2048 by 1536 pixels:
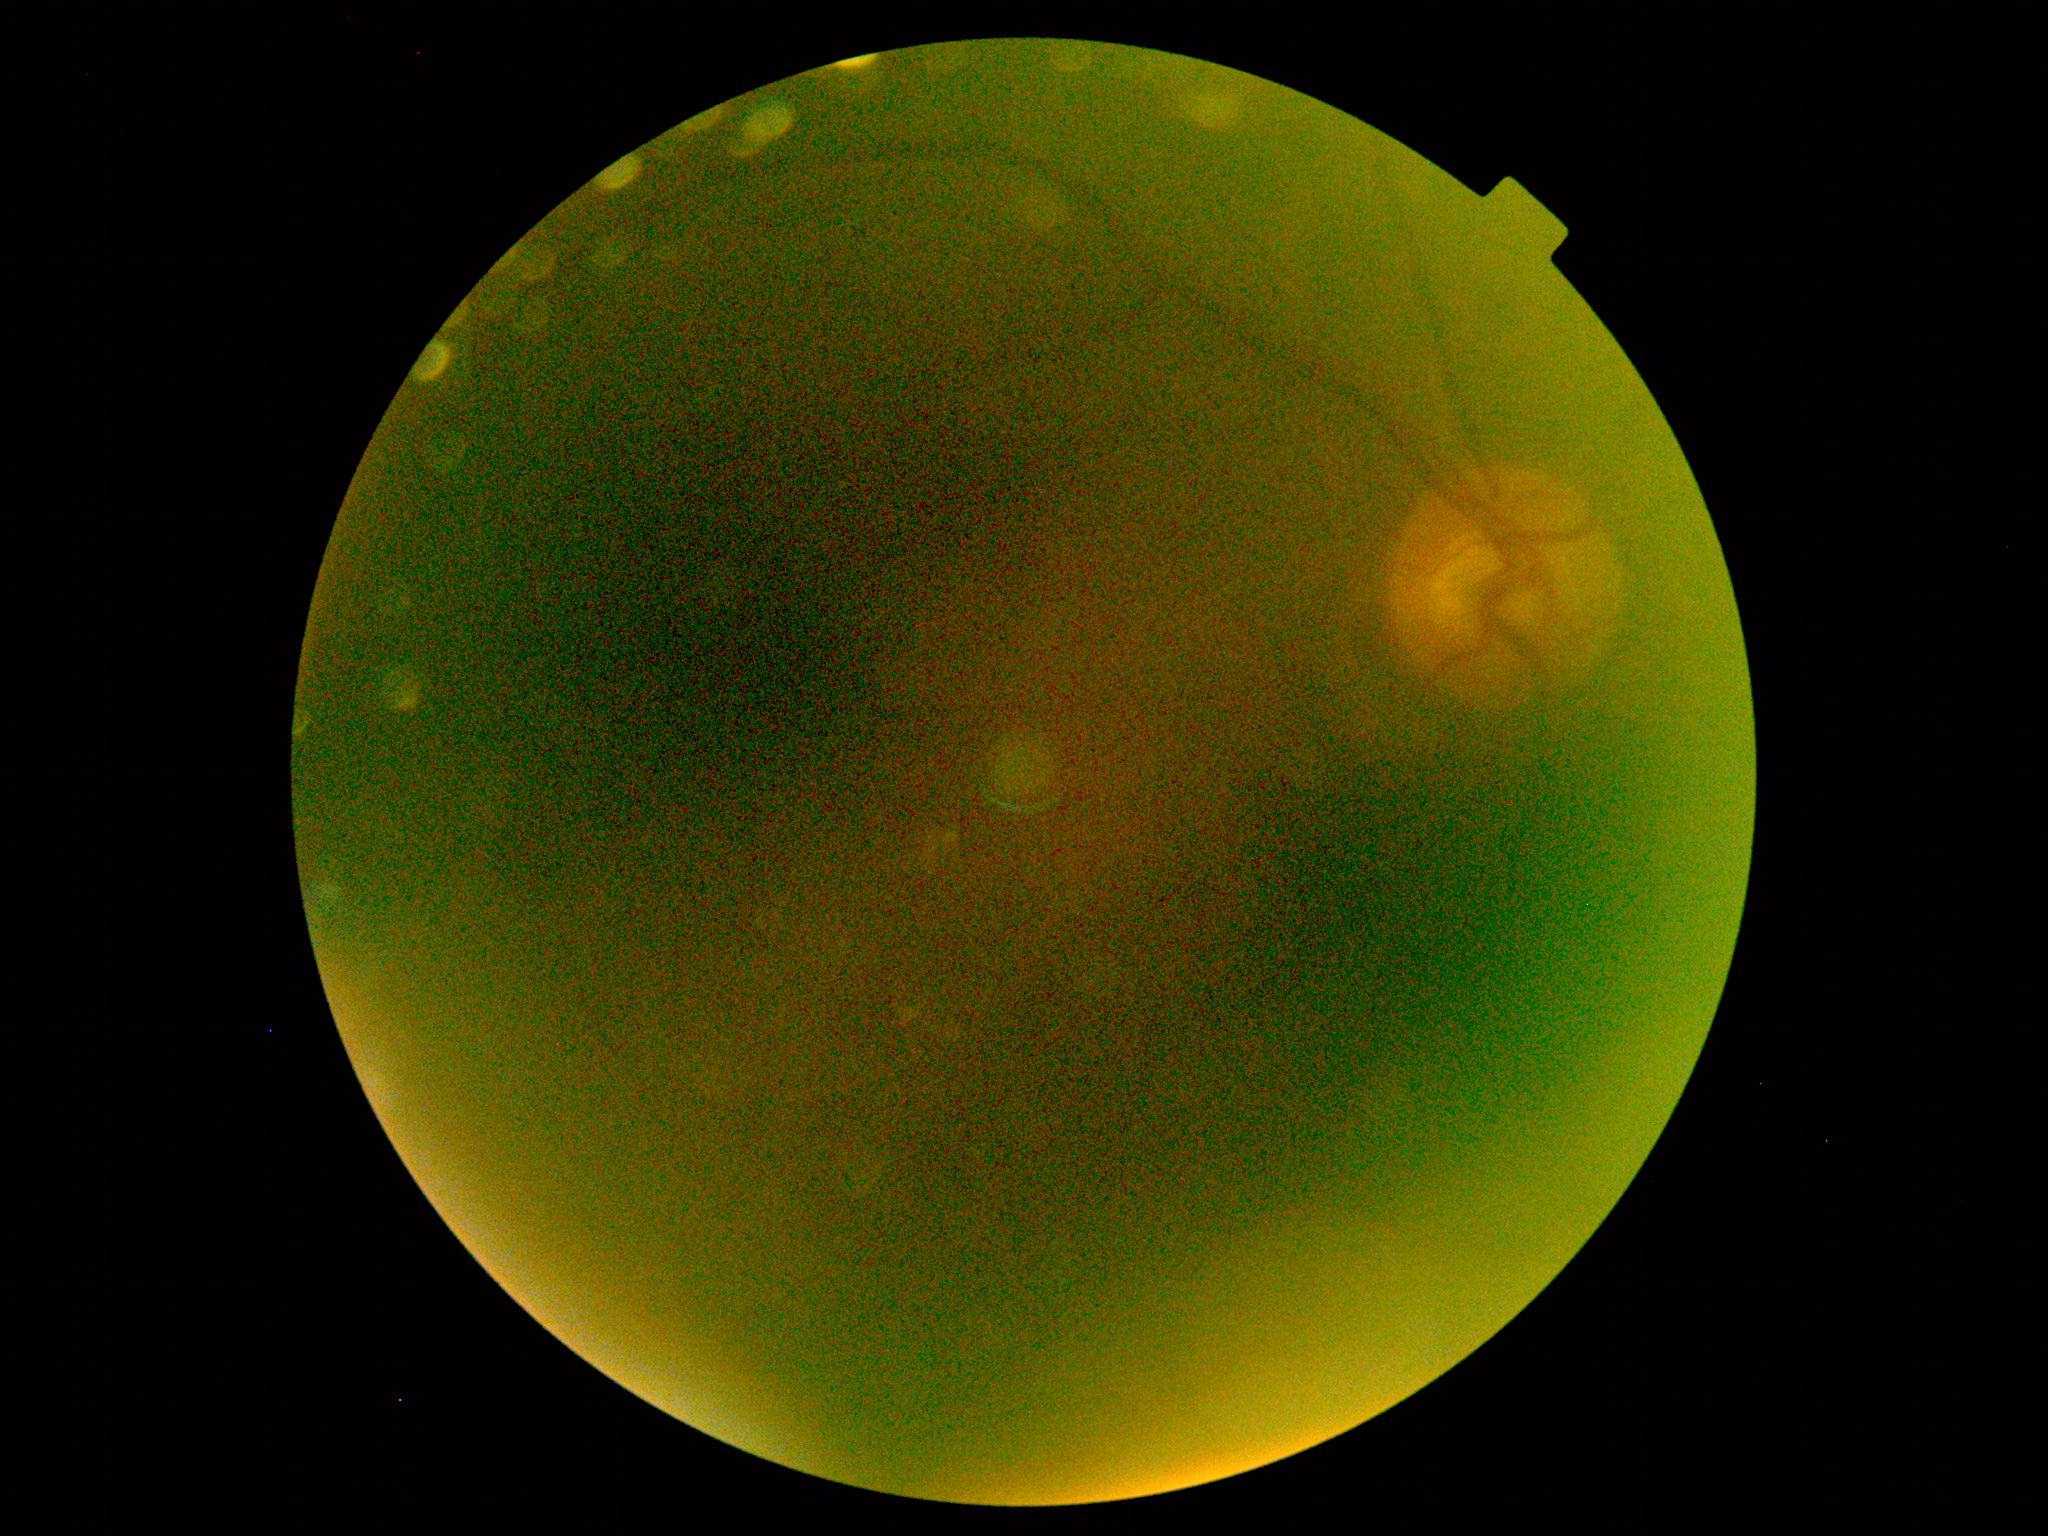

image quality: below grading threshold, DR severity: ungradable due to poor image quality.